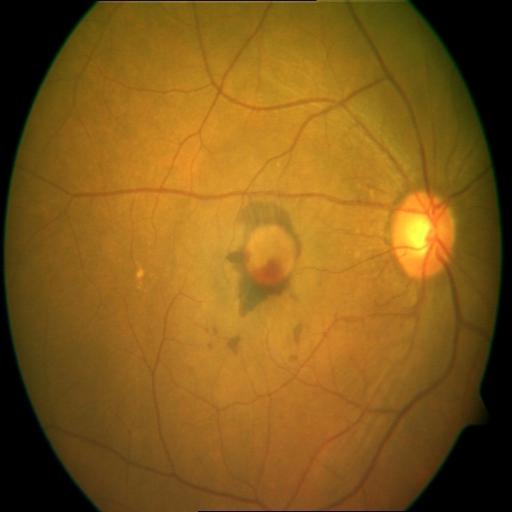
Pathology (4):
- CRS (chorioretinitis)
- MH (media haze)
- HPED (hemorrhagic pigment epithelial detachment)
- MS (macular scar)